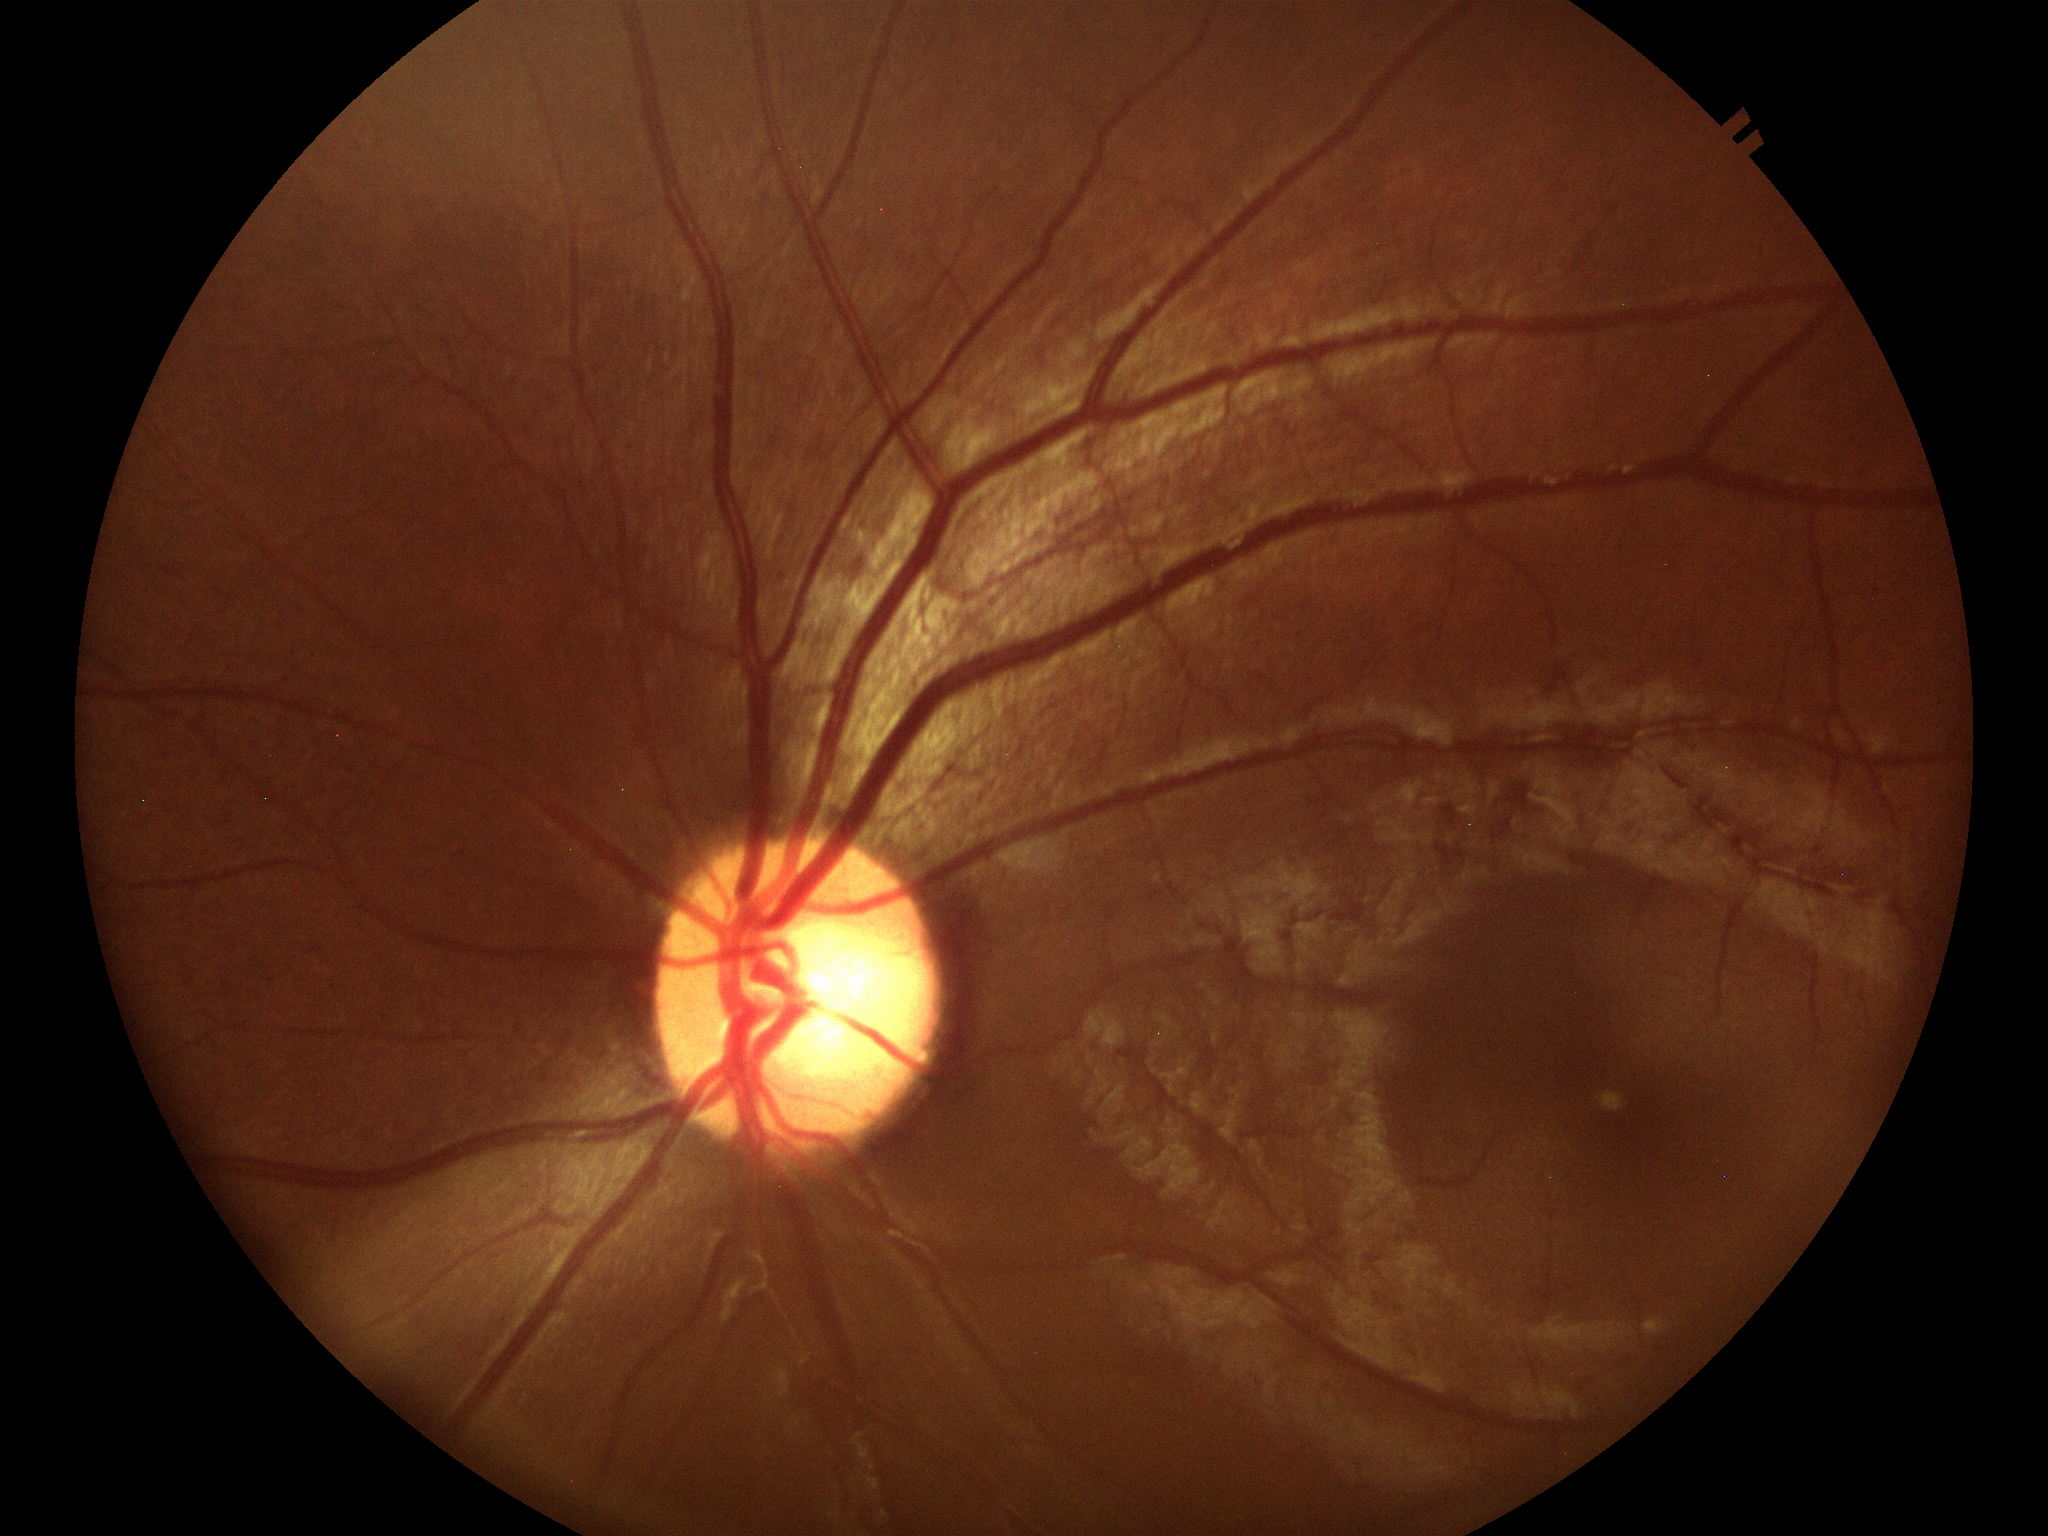
Q: Glaucoma screening result?
A: not suspect (5/5 ophthalmologists in agreement)
Q: What is the VCDR?
A: 0.57
Q: What is the area cup-to-disc ratio?
A: 0.35